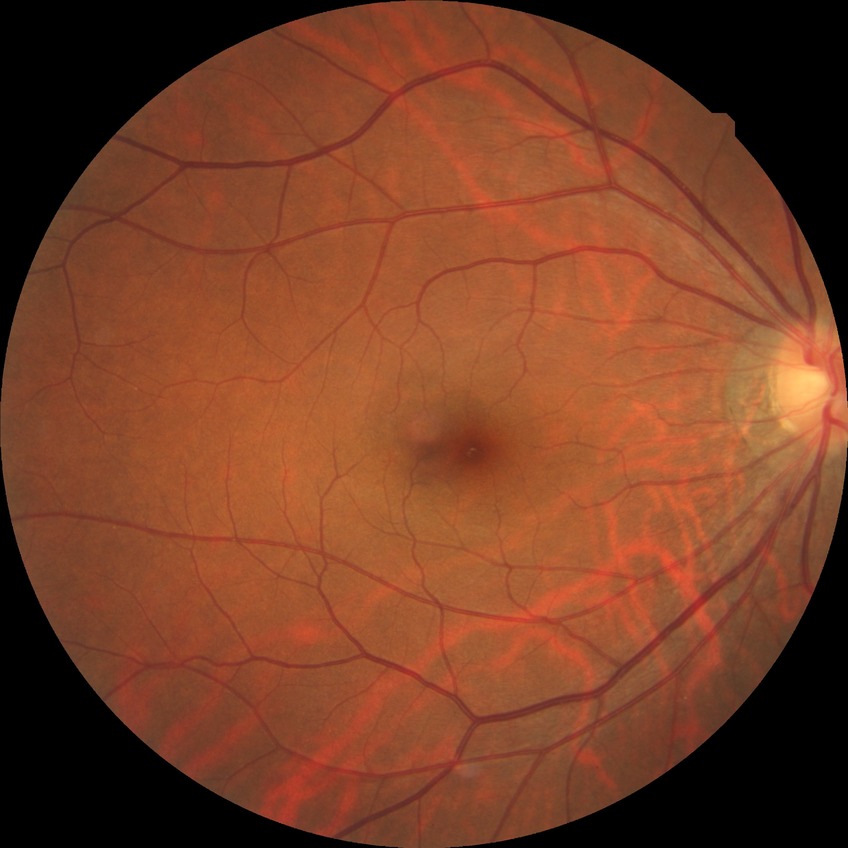
Diabetic retinopathy (DR): NDR (no diabetic retinopathy).